Nonmydriatic
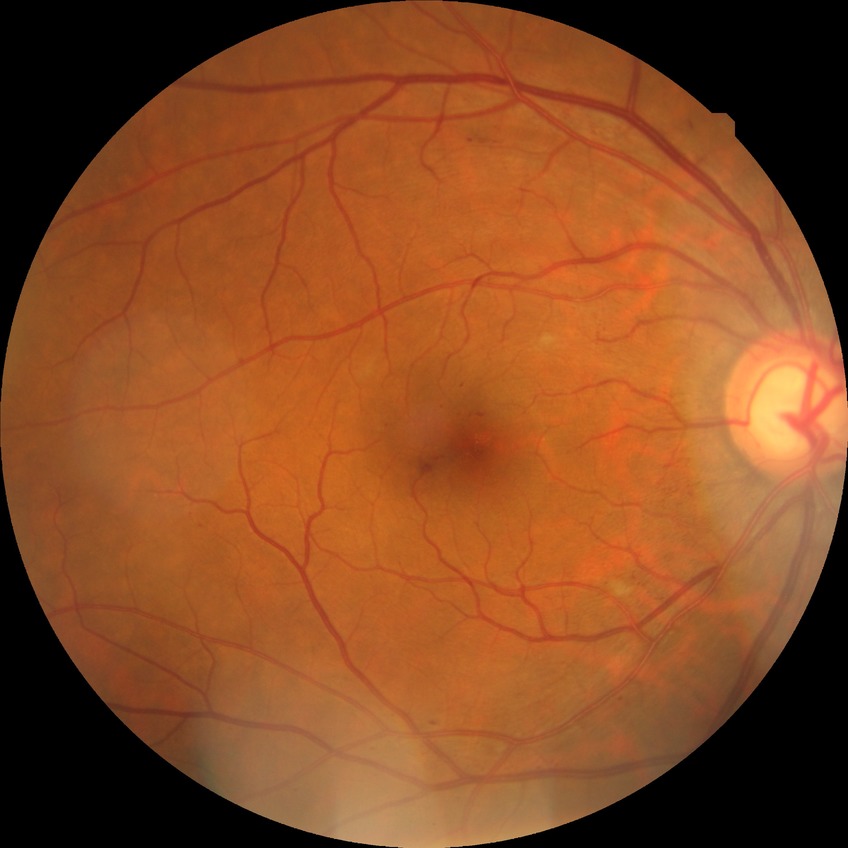

DR class = non-proliferative diabetic retinopathy | DR severity = SDR.